Phoenix ICON, 100° FOV · 1240 by 1240 pixels · Phoenix ICON wide-field infant fundus image: 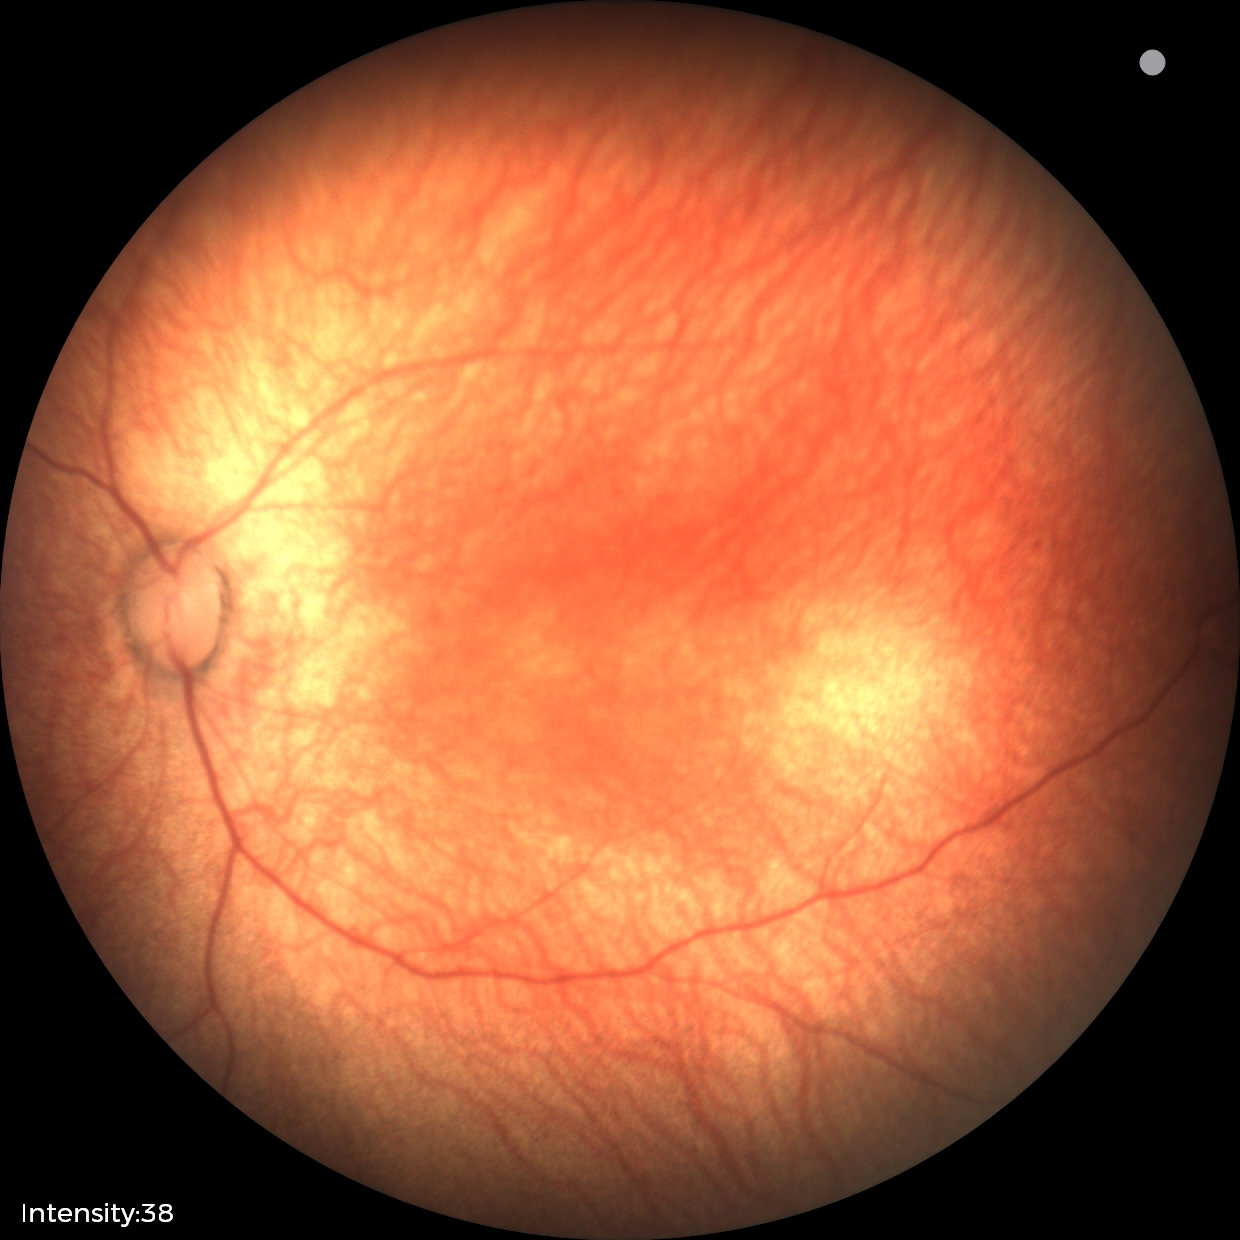 No retinal pathology identified on screening.